Nonmydriatic:
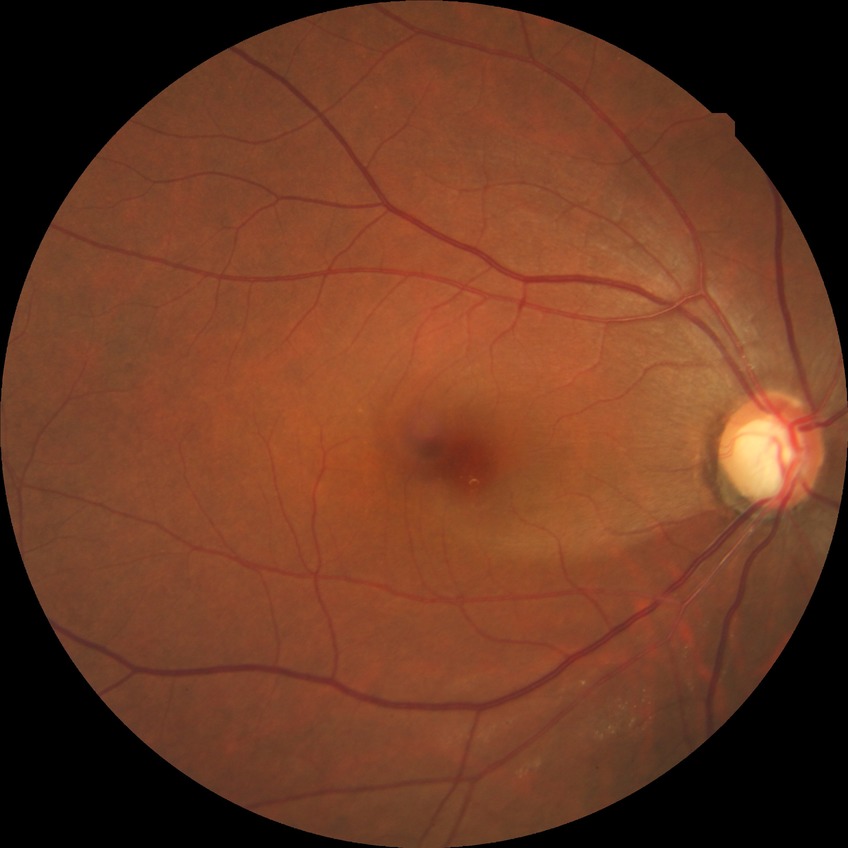
  davis_grade: no diabetic retinopathy